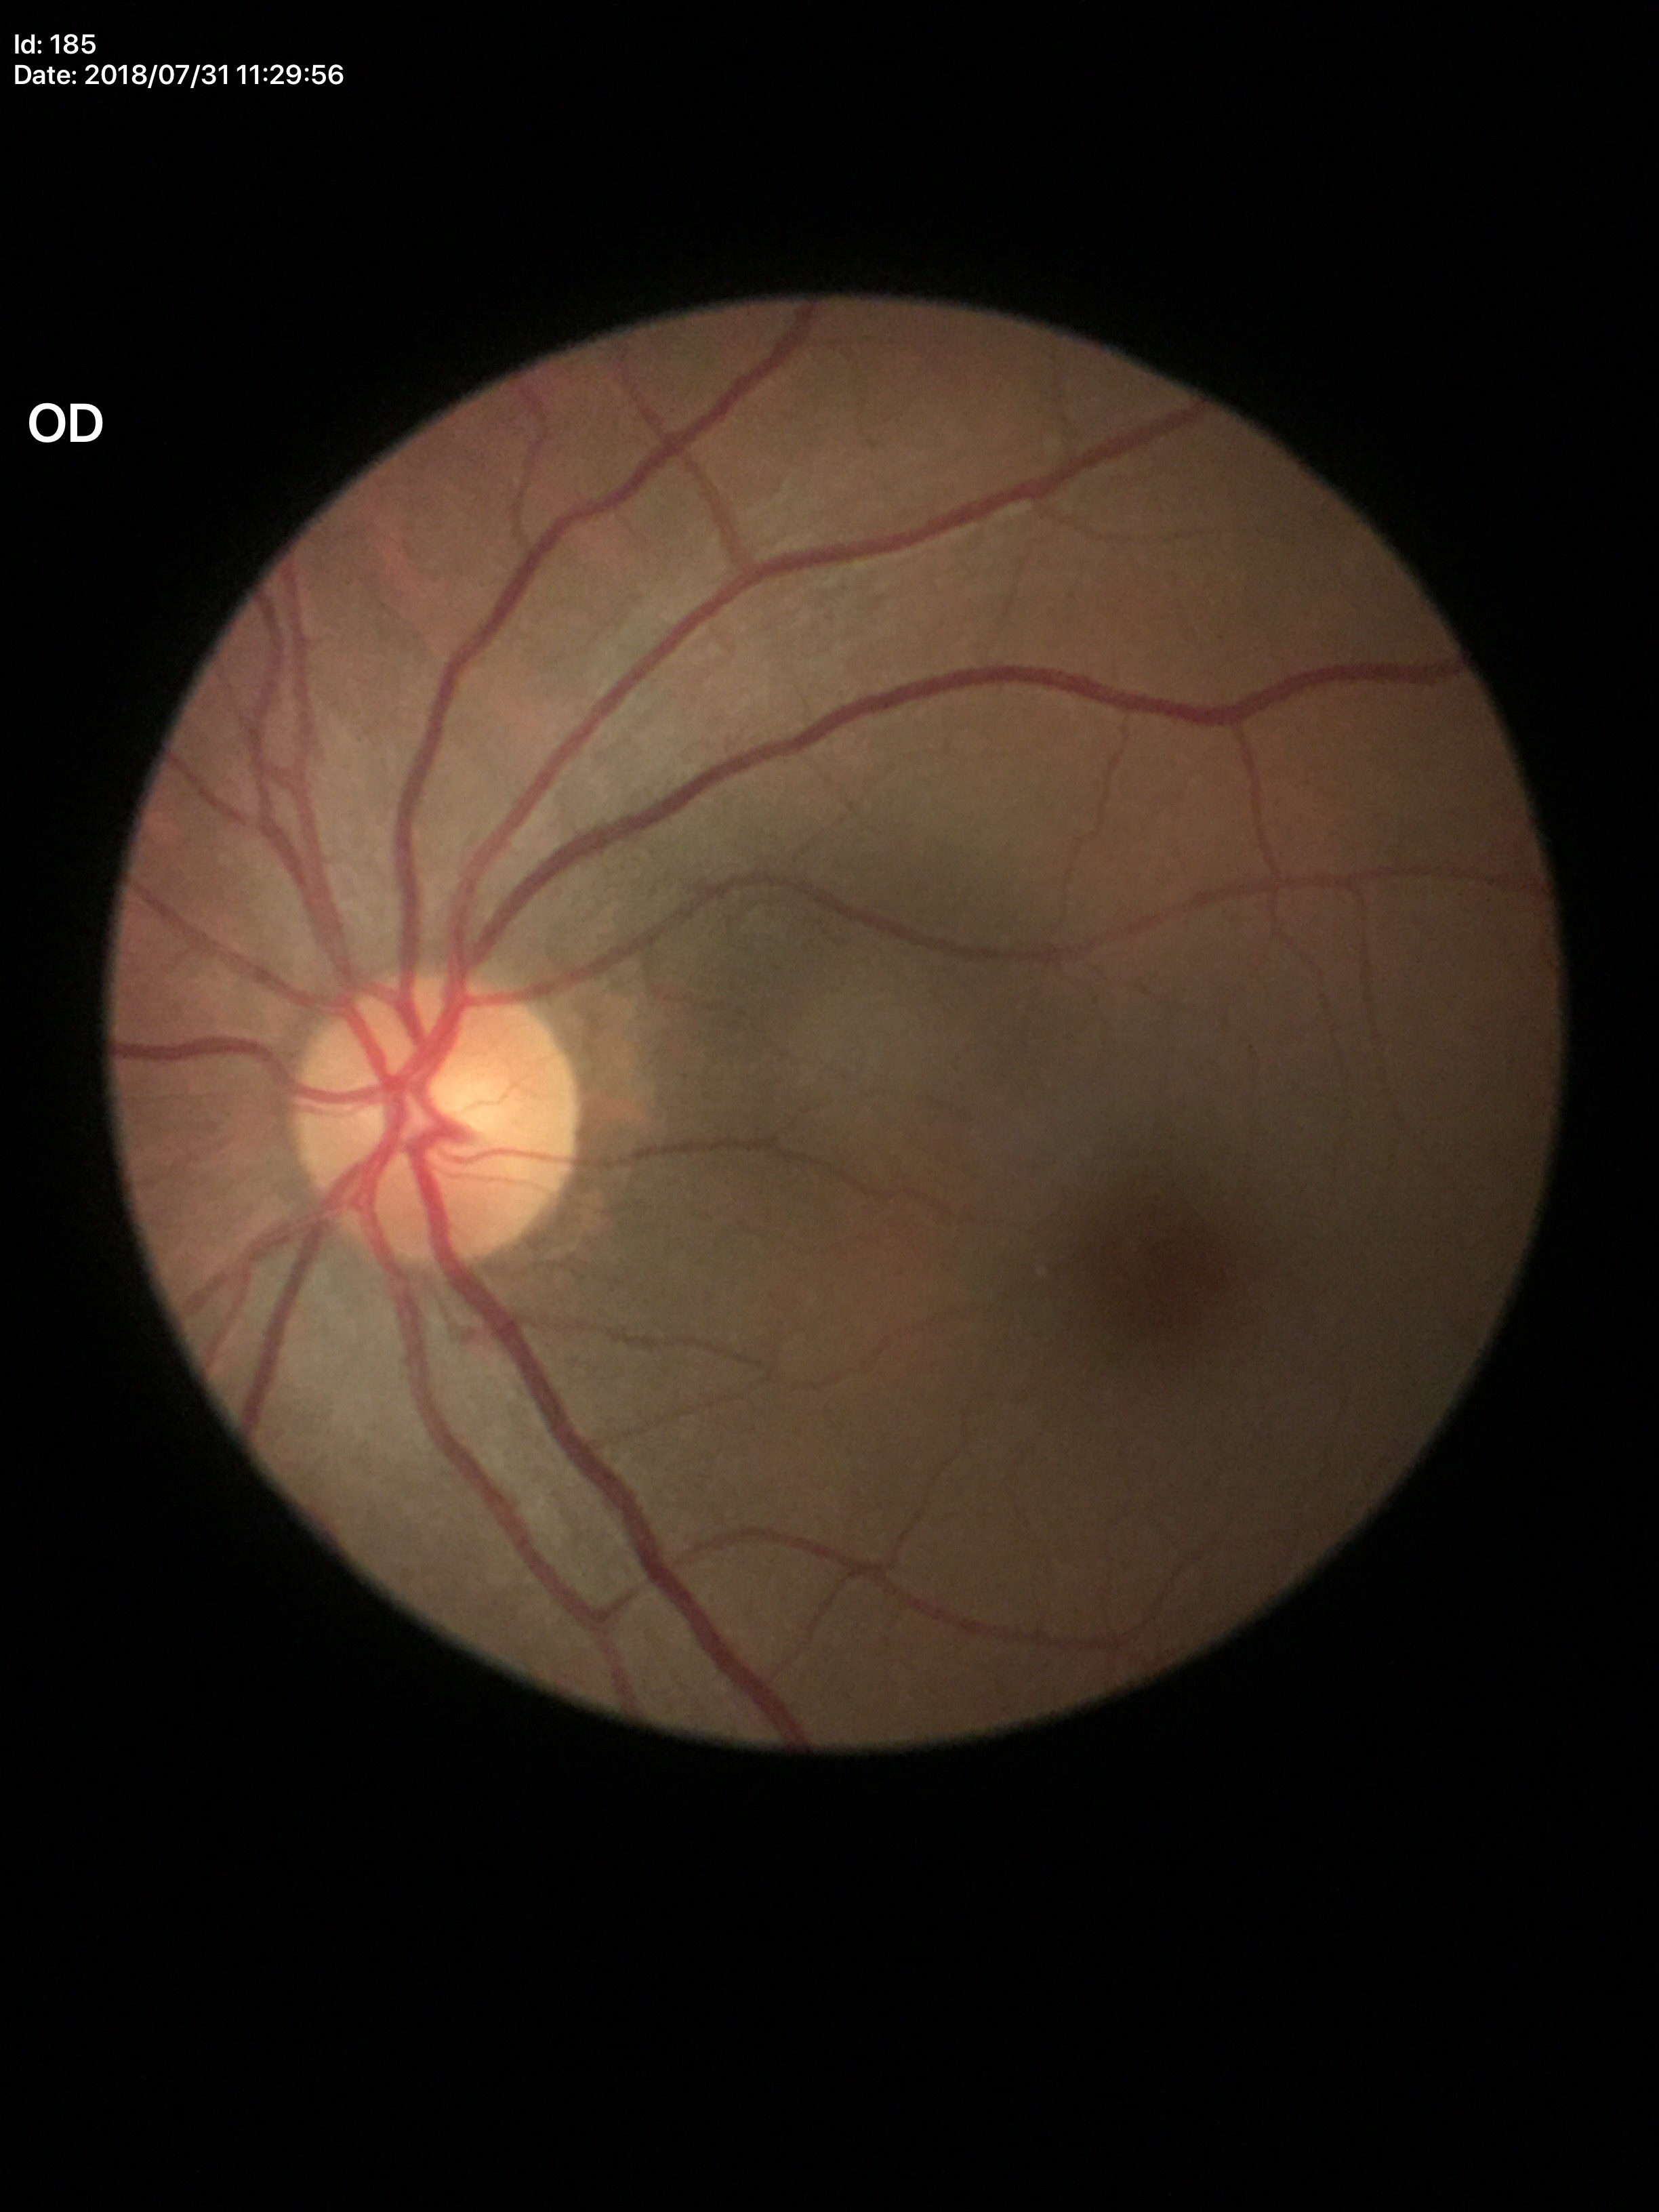
Glaucoma assessment: not suspect; area CDR (ACDR): 0.21; vertical cup-to-disc ratio (VCDR): 0.44